Color fundus photograph — 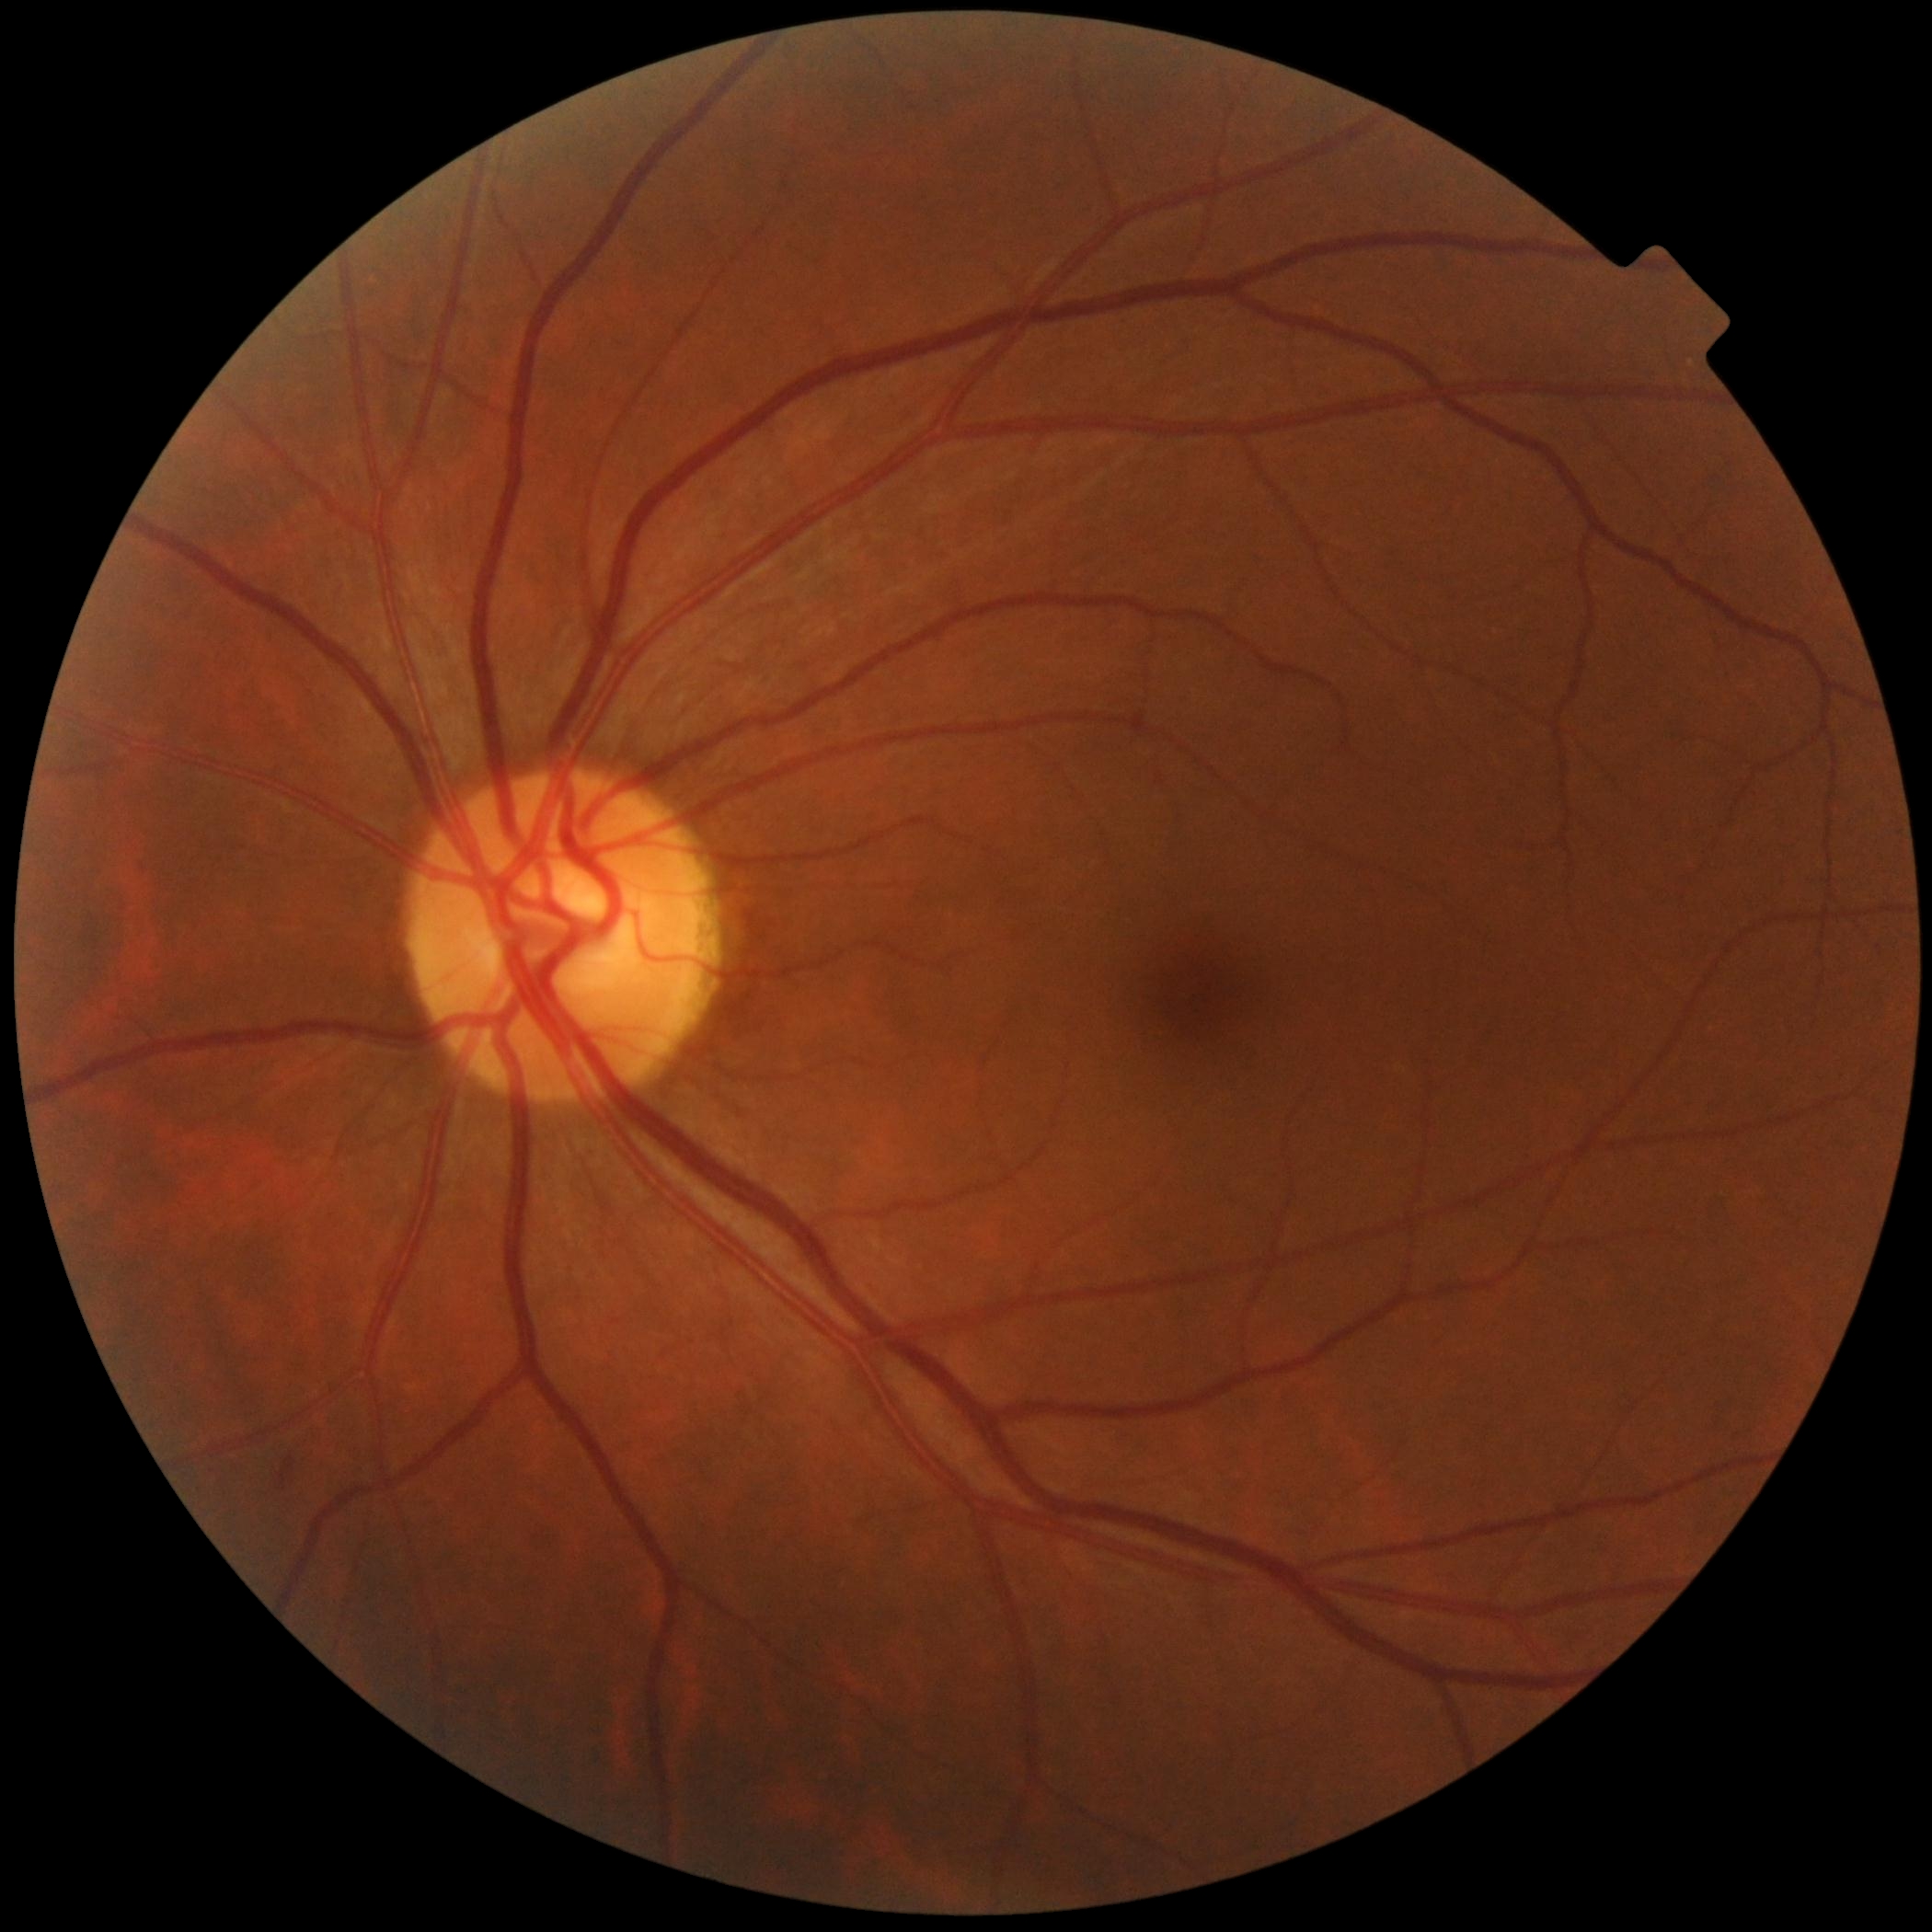 diabetic retinopathy severity: 0/4.